No pharmacologic dilation, 45-degree field of view, CFP — 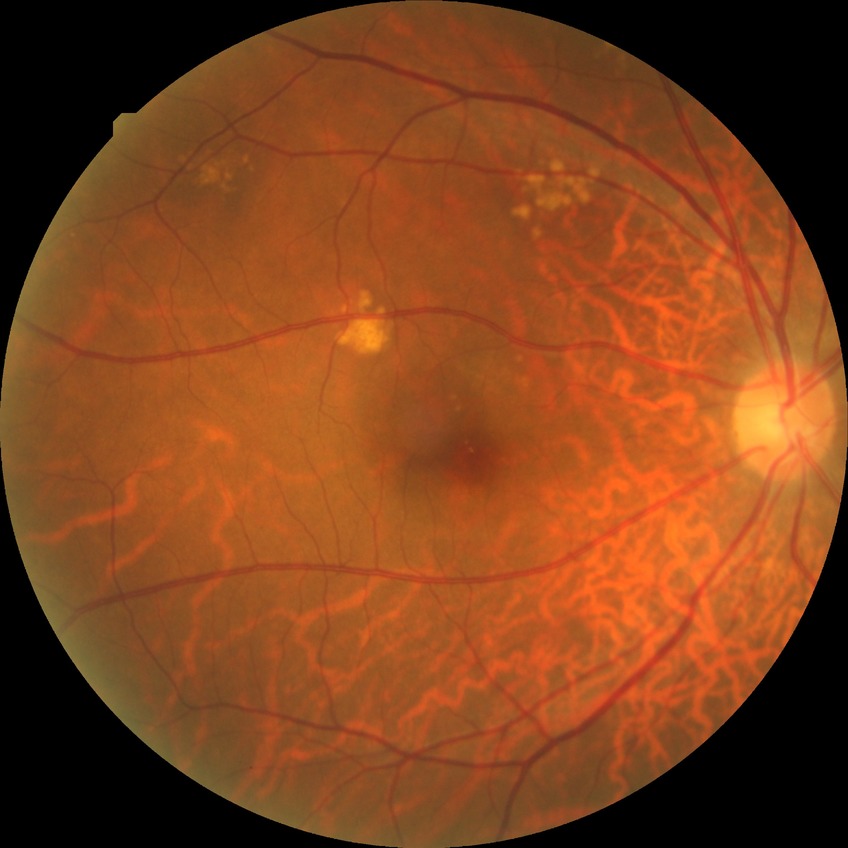 Diabetic retinopathy severity is no diabetic retinopathy.